Camera: Phoenix ICON (100° FOV). Pediatric wide-field fundus photograph. 1240 x 1240 pixels: 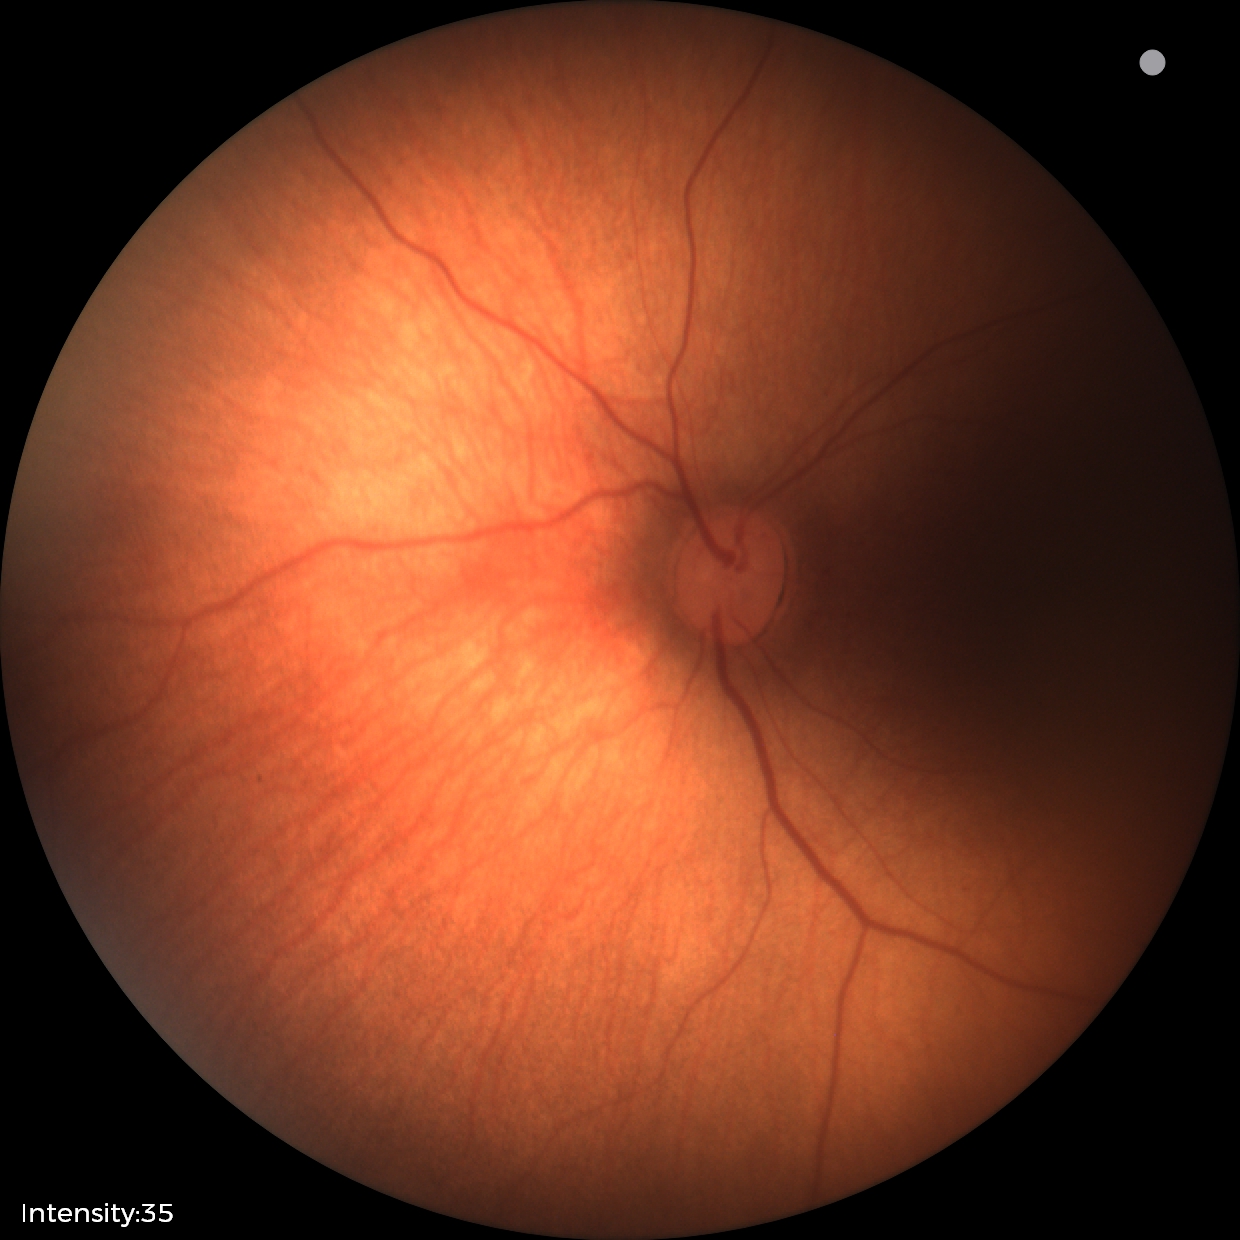 Normal screening examination.